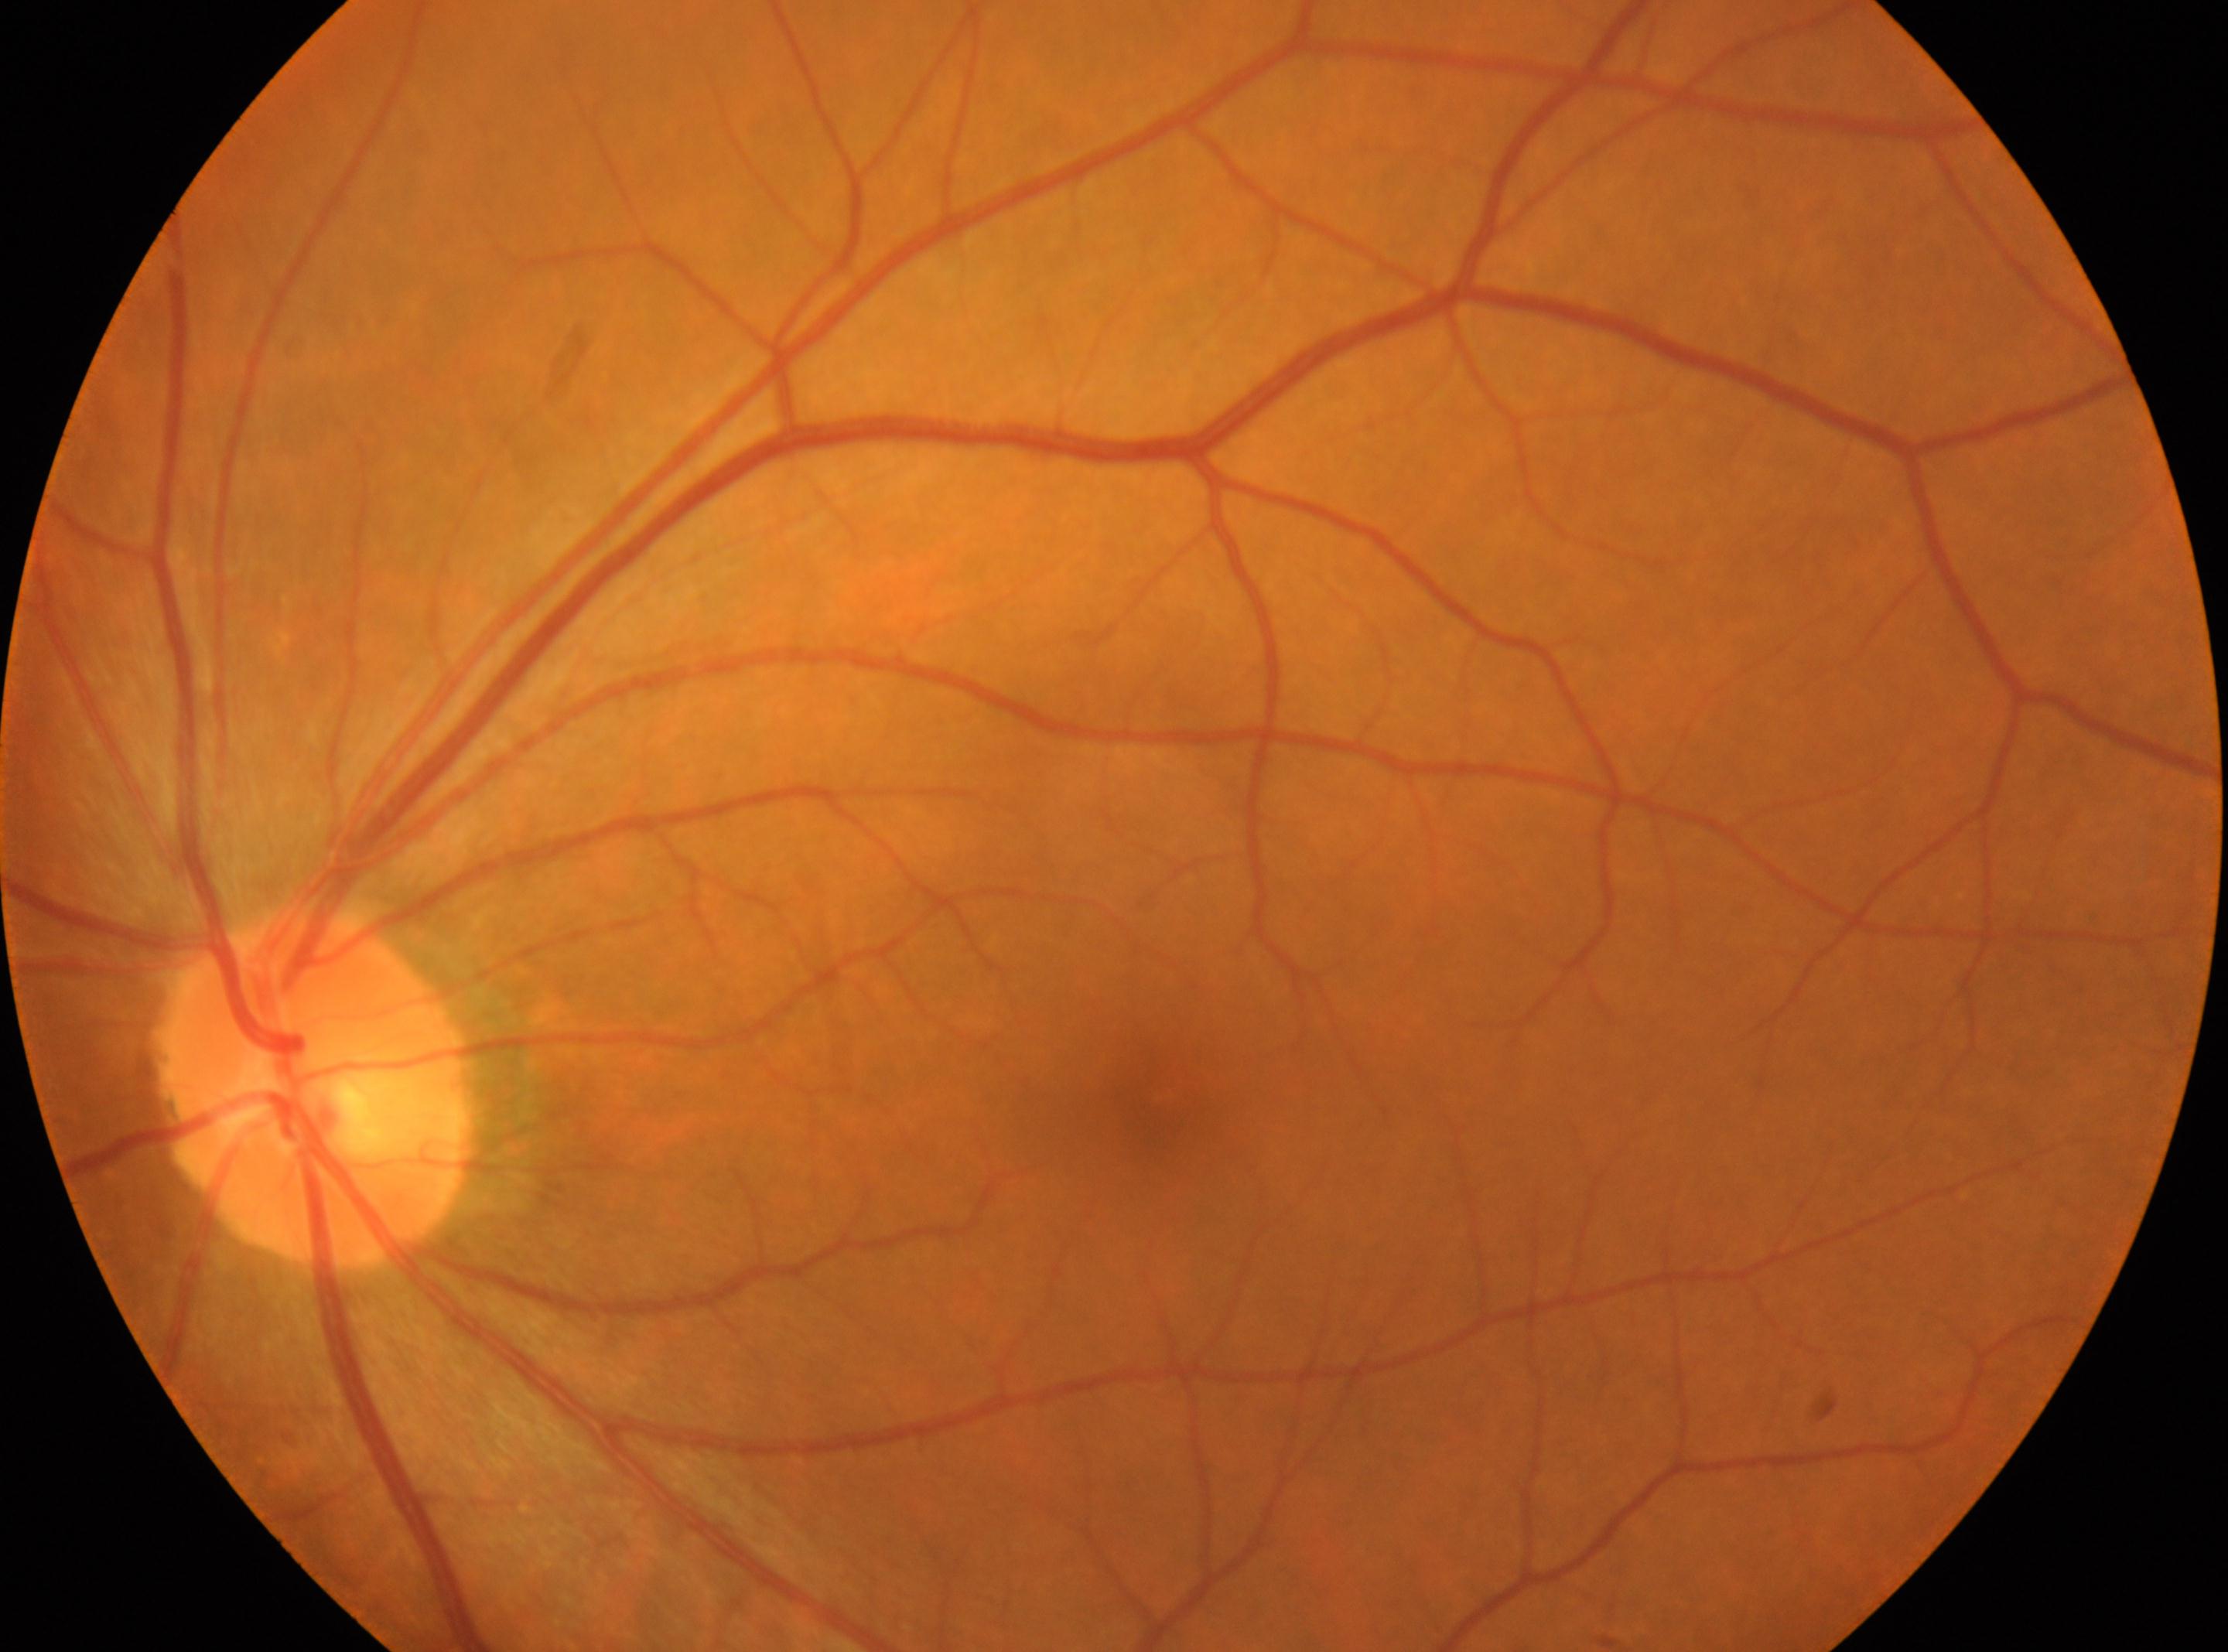 This is the left eye. Fovea centralis: (x: 1151, y: 1100). No diabetic retinopathy identified. Retinopathy grade is 0. ONH: (x: 313, y: 1086).